1659x2212px — 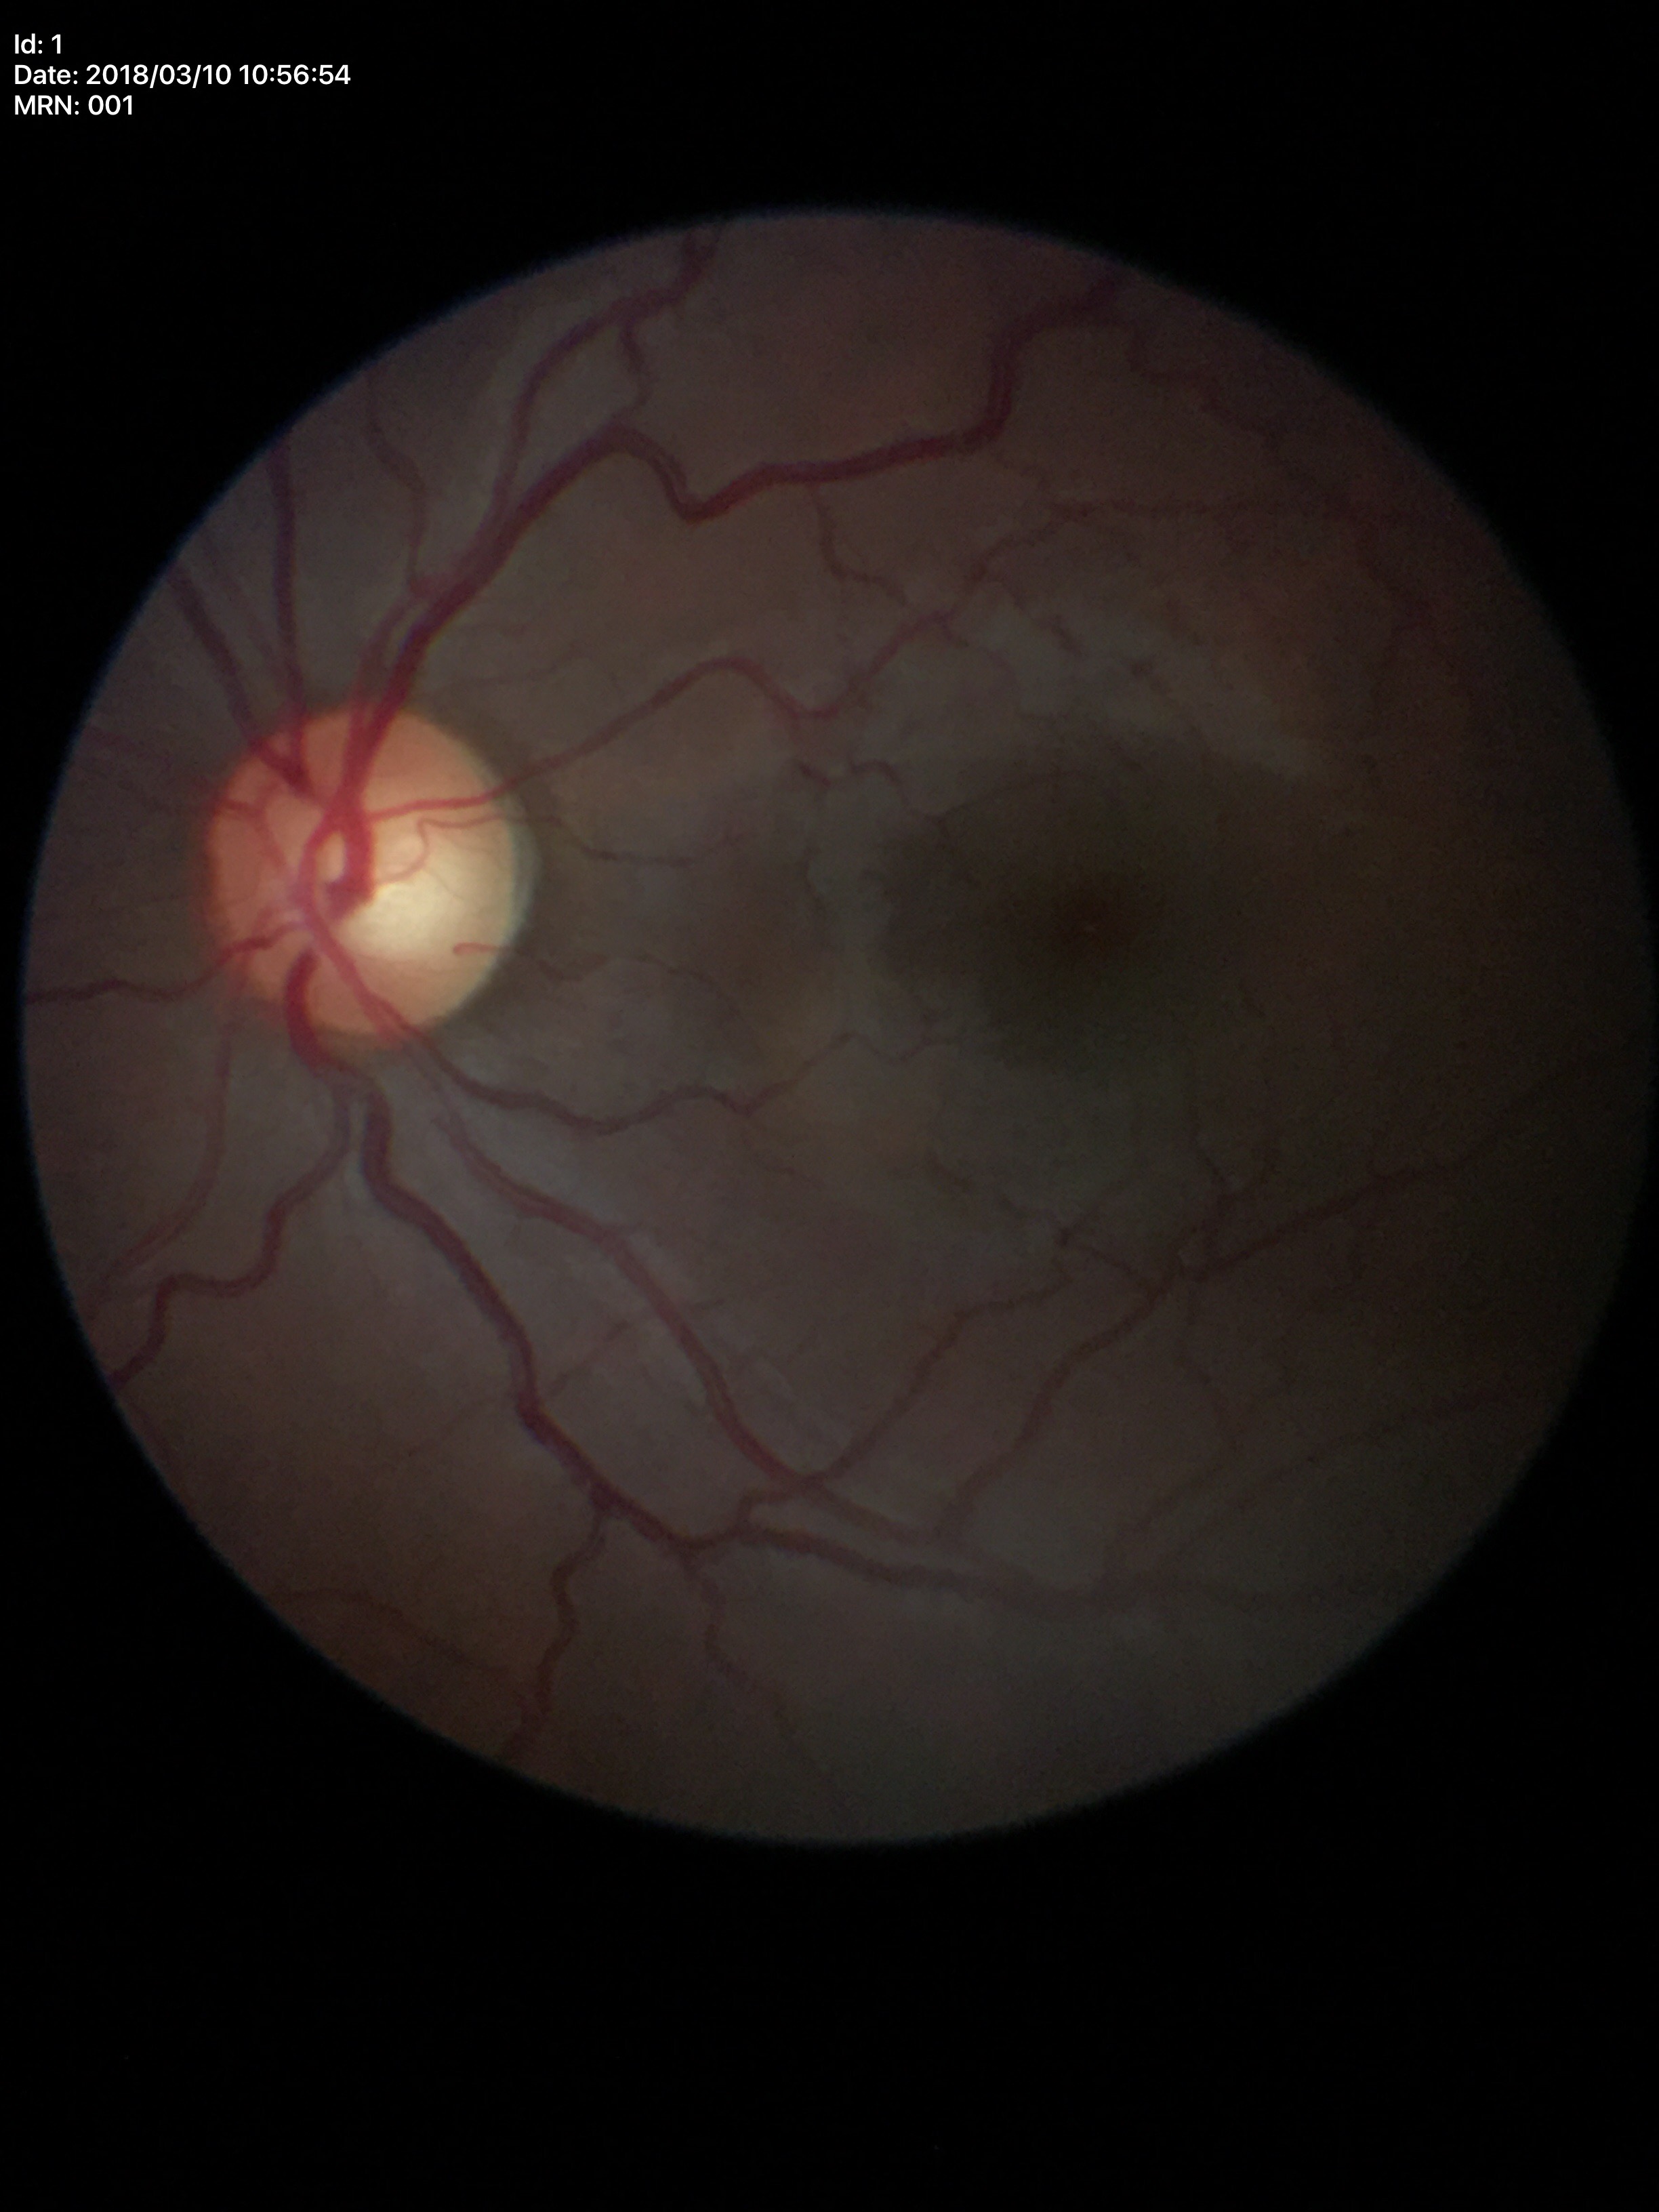 glaucoma_decision: not suspect
vcdr: 0.51
hcdr: 0.57